Captured with the Phoenix ICON (100° field of view). Infant wide-field fundus photograph. Image size 1240x1240.
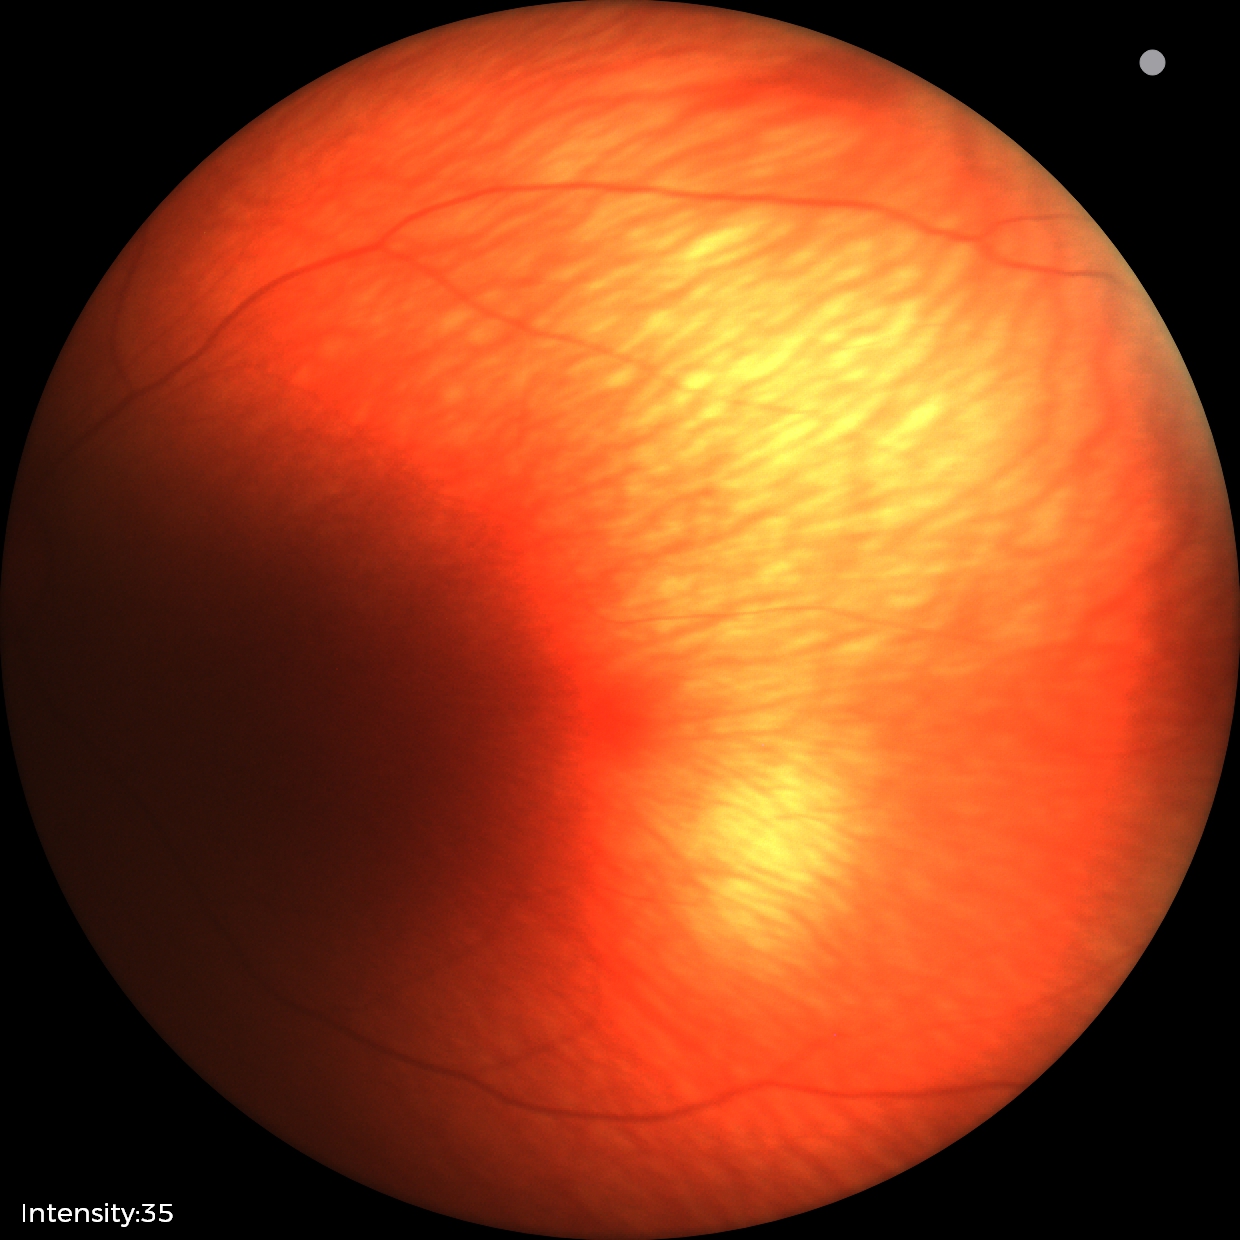 Examination with physiological retinal findings.